Color fundus image
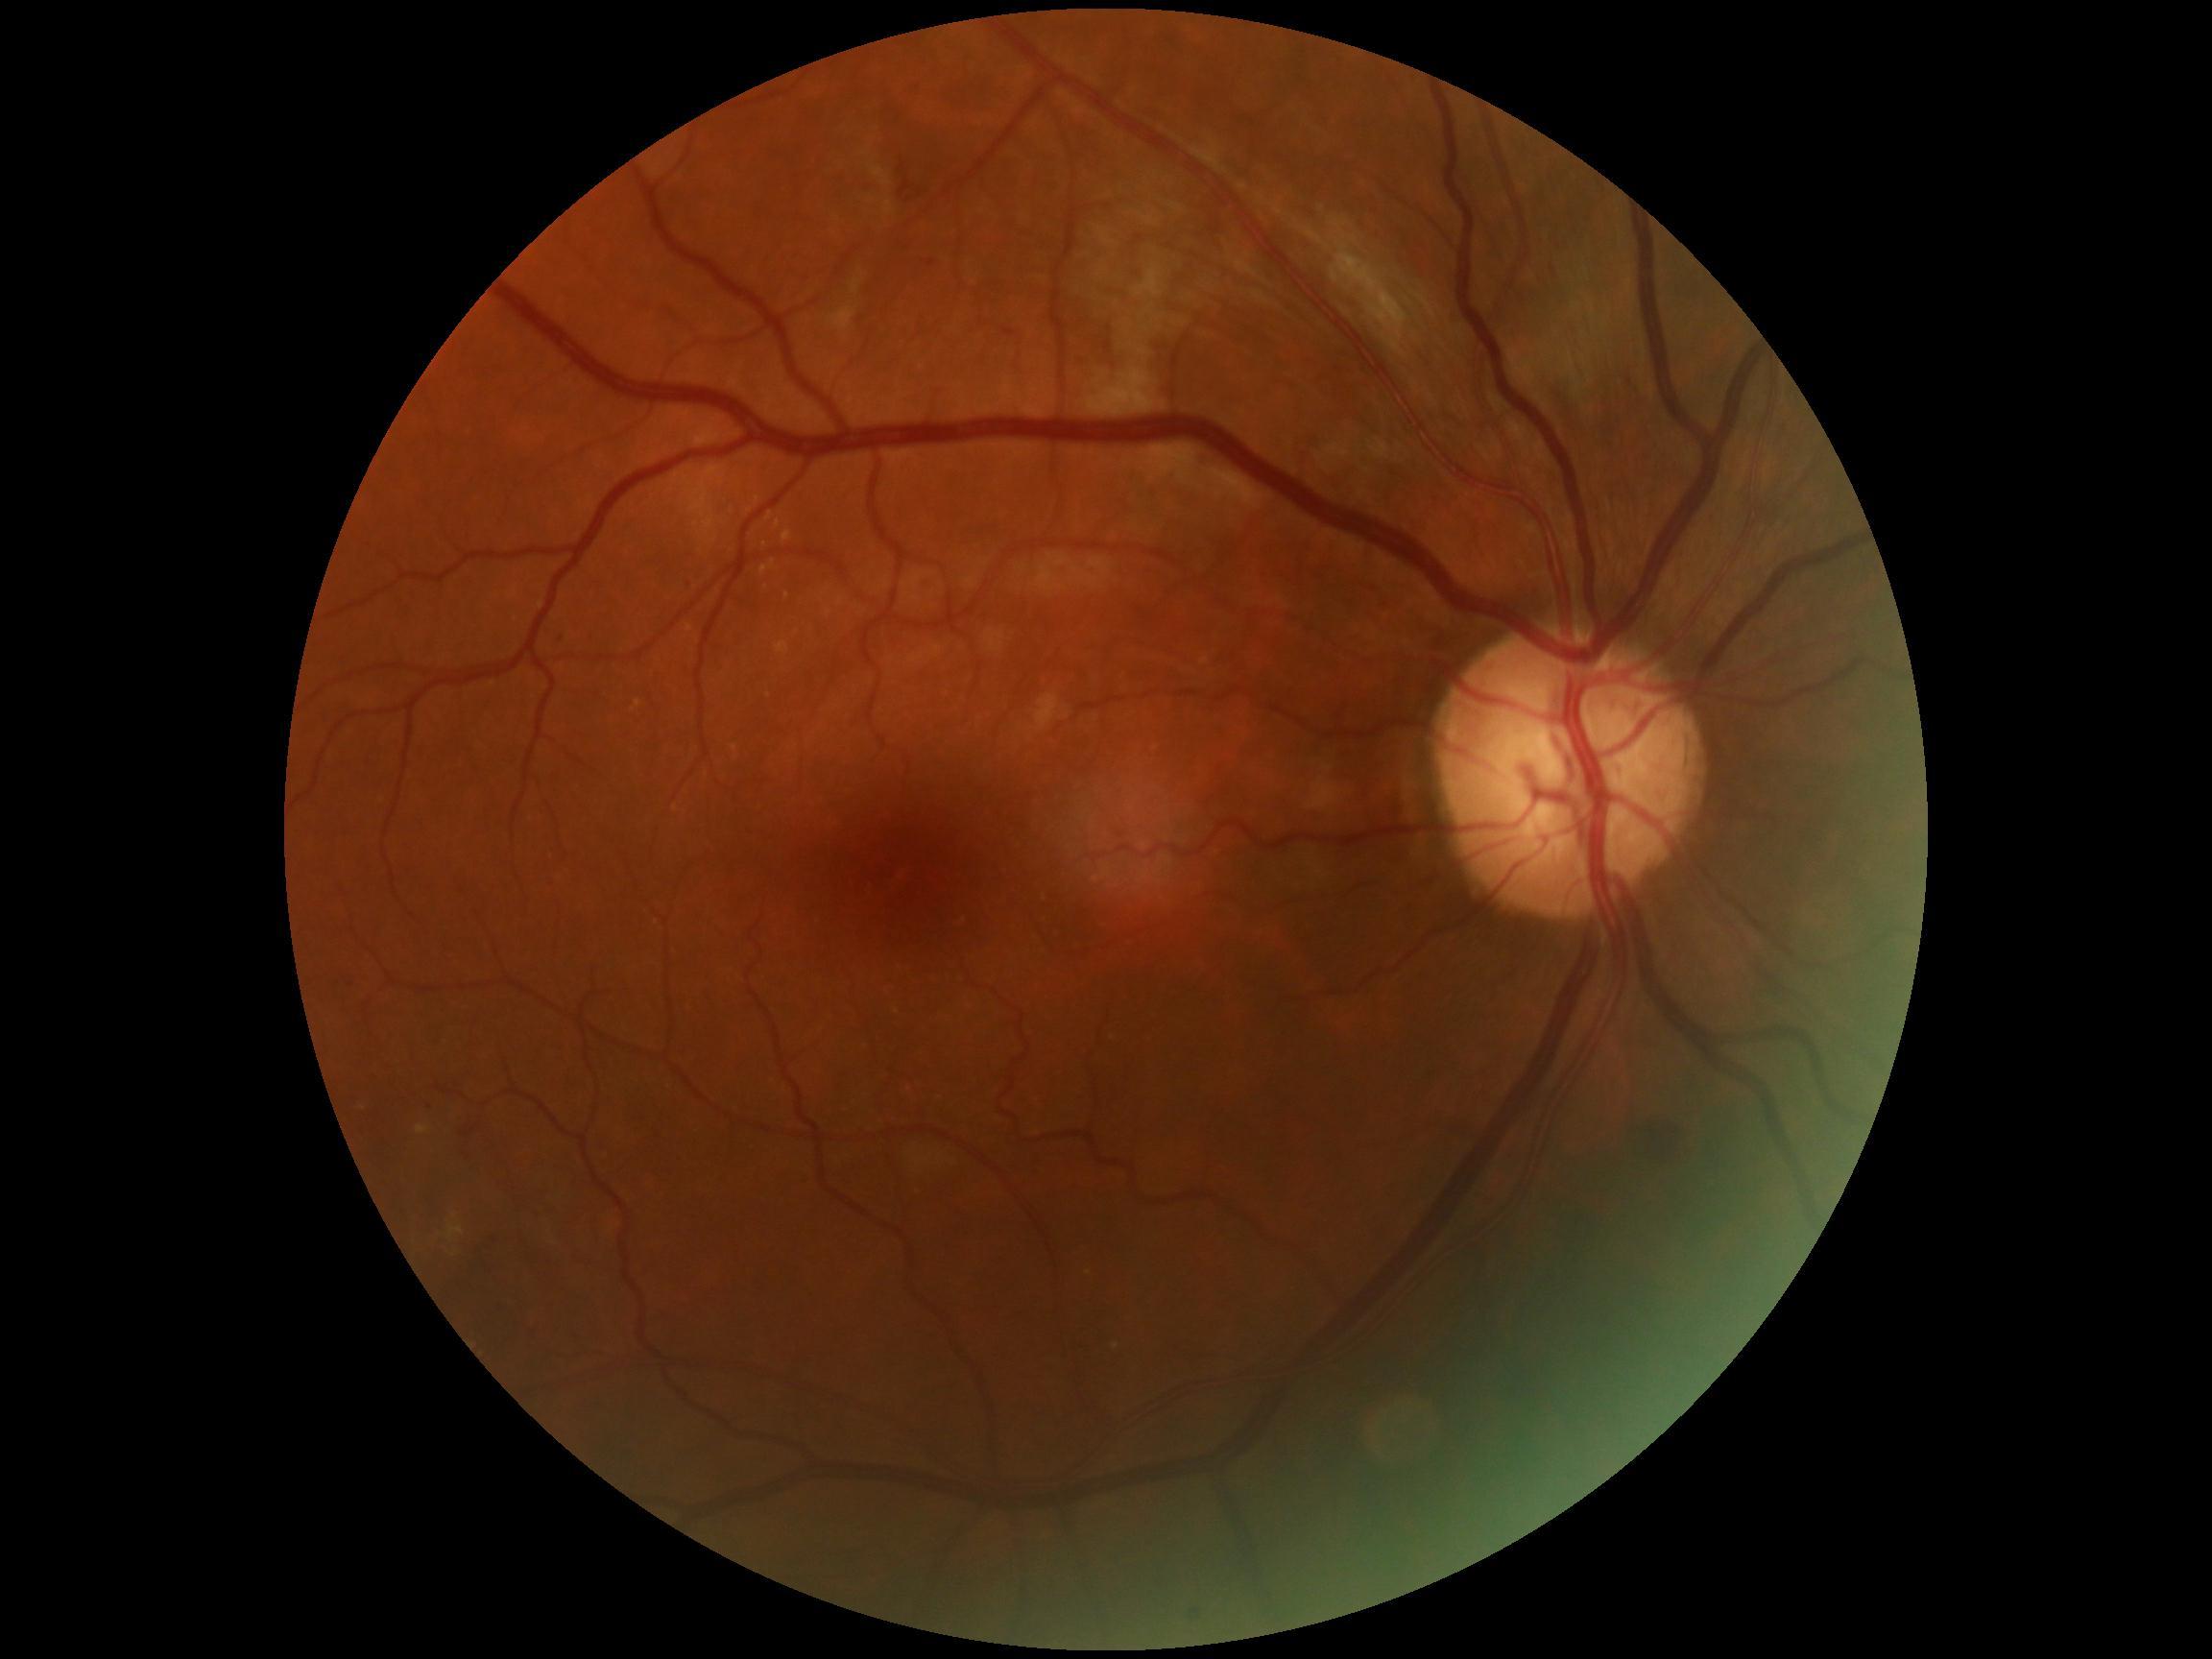
* diabetic retinopathy (DR): 2/4